Ultra-widefield fundus mosaic — 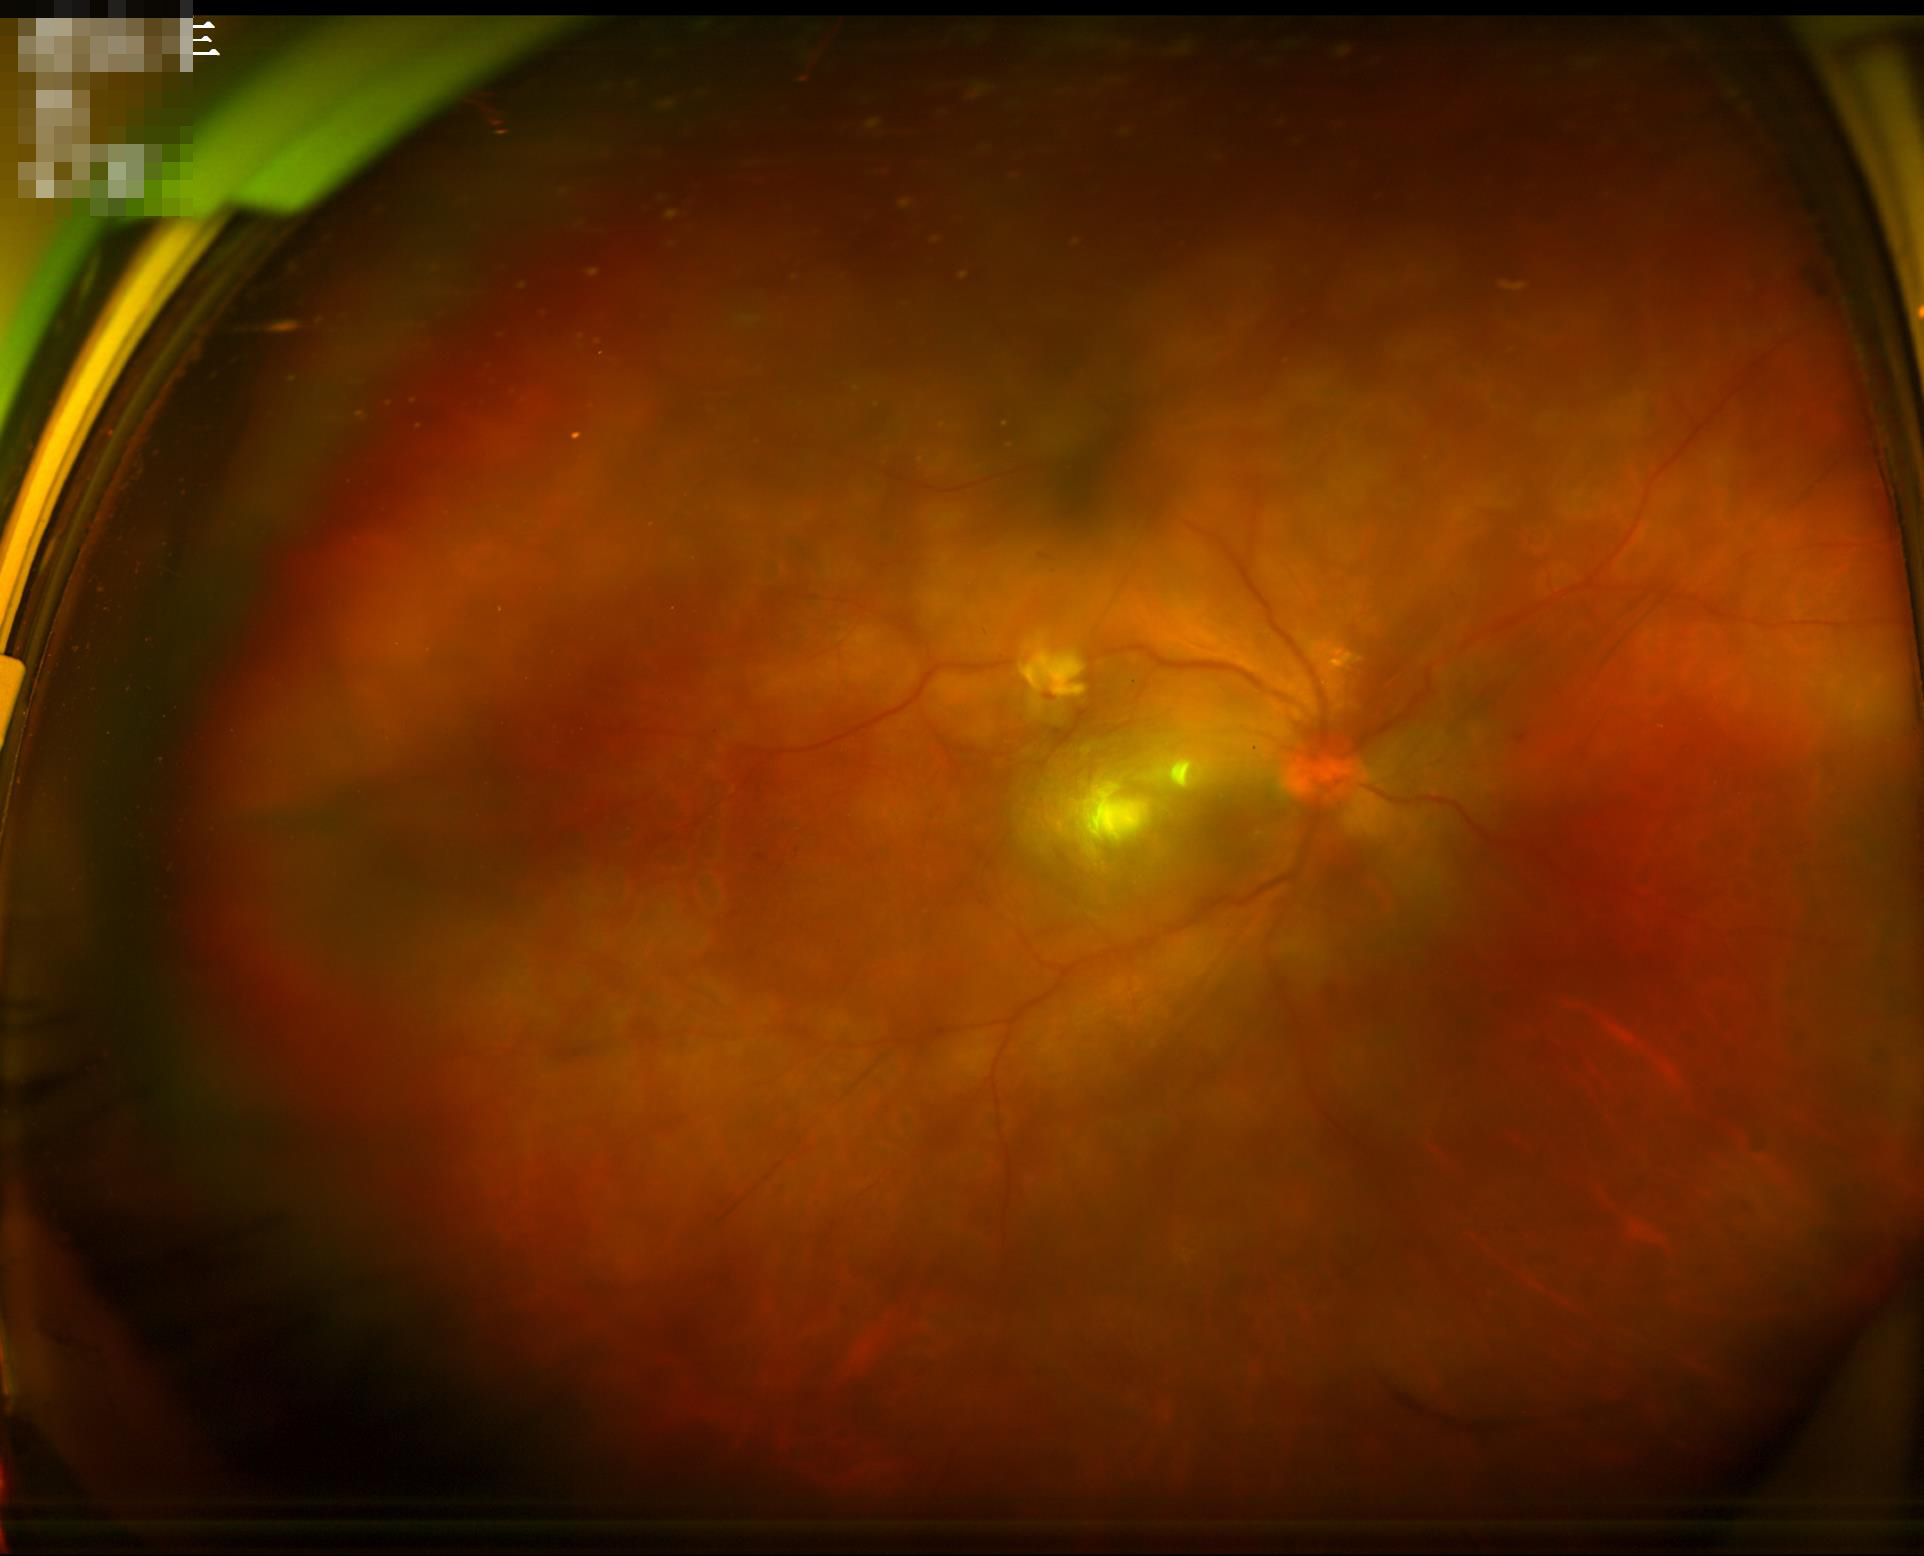

{
  "illumination": "even",
  "contrast": "adequate",
  "clarity": "poor",
  "overall_quality": "suboptimal"
}